130° field of view (Natus RetCam Envision); image size 1440x1080; wide-field fundus photograph of an infant: 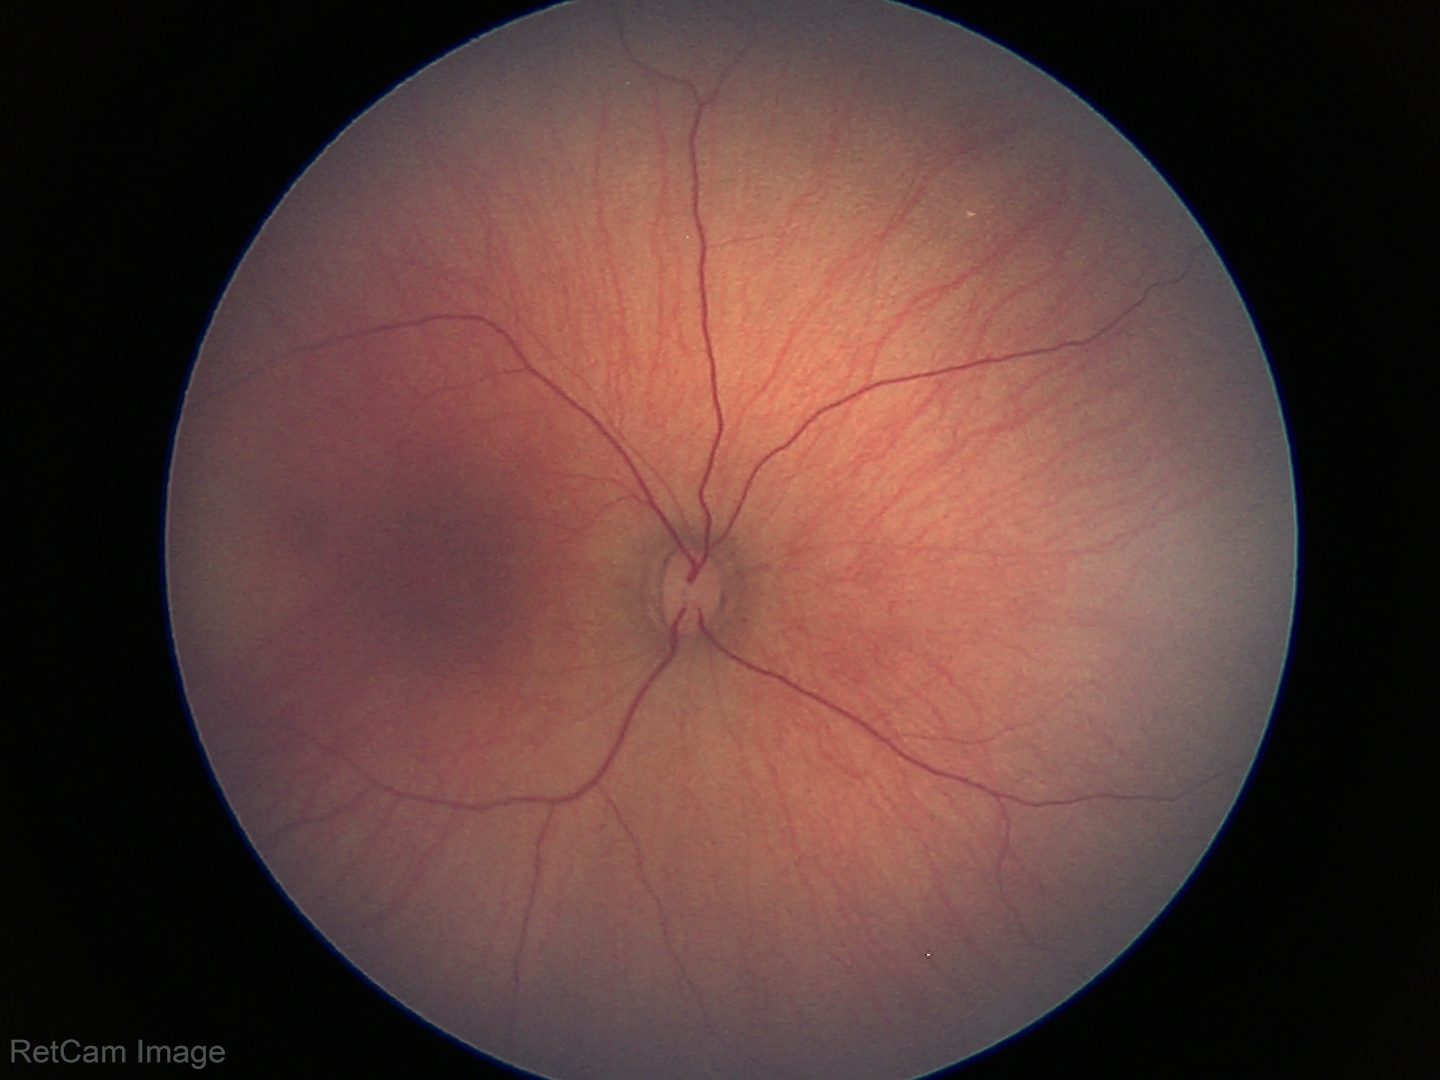
Diagnosis = normal.